2352 x 1568 pixels; retinal fundus photograph; 45° FOV — 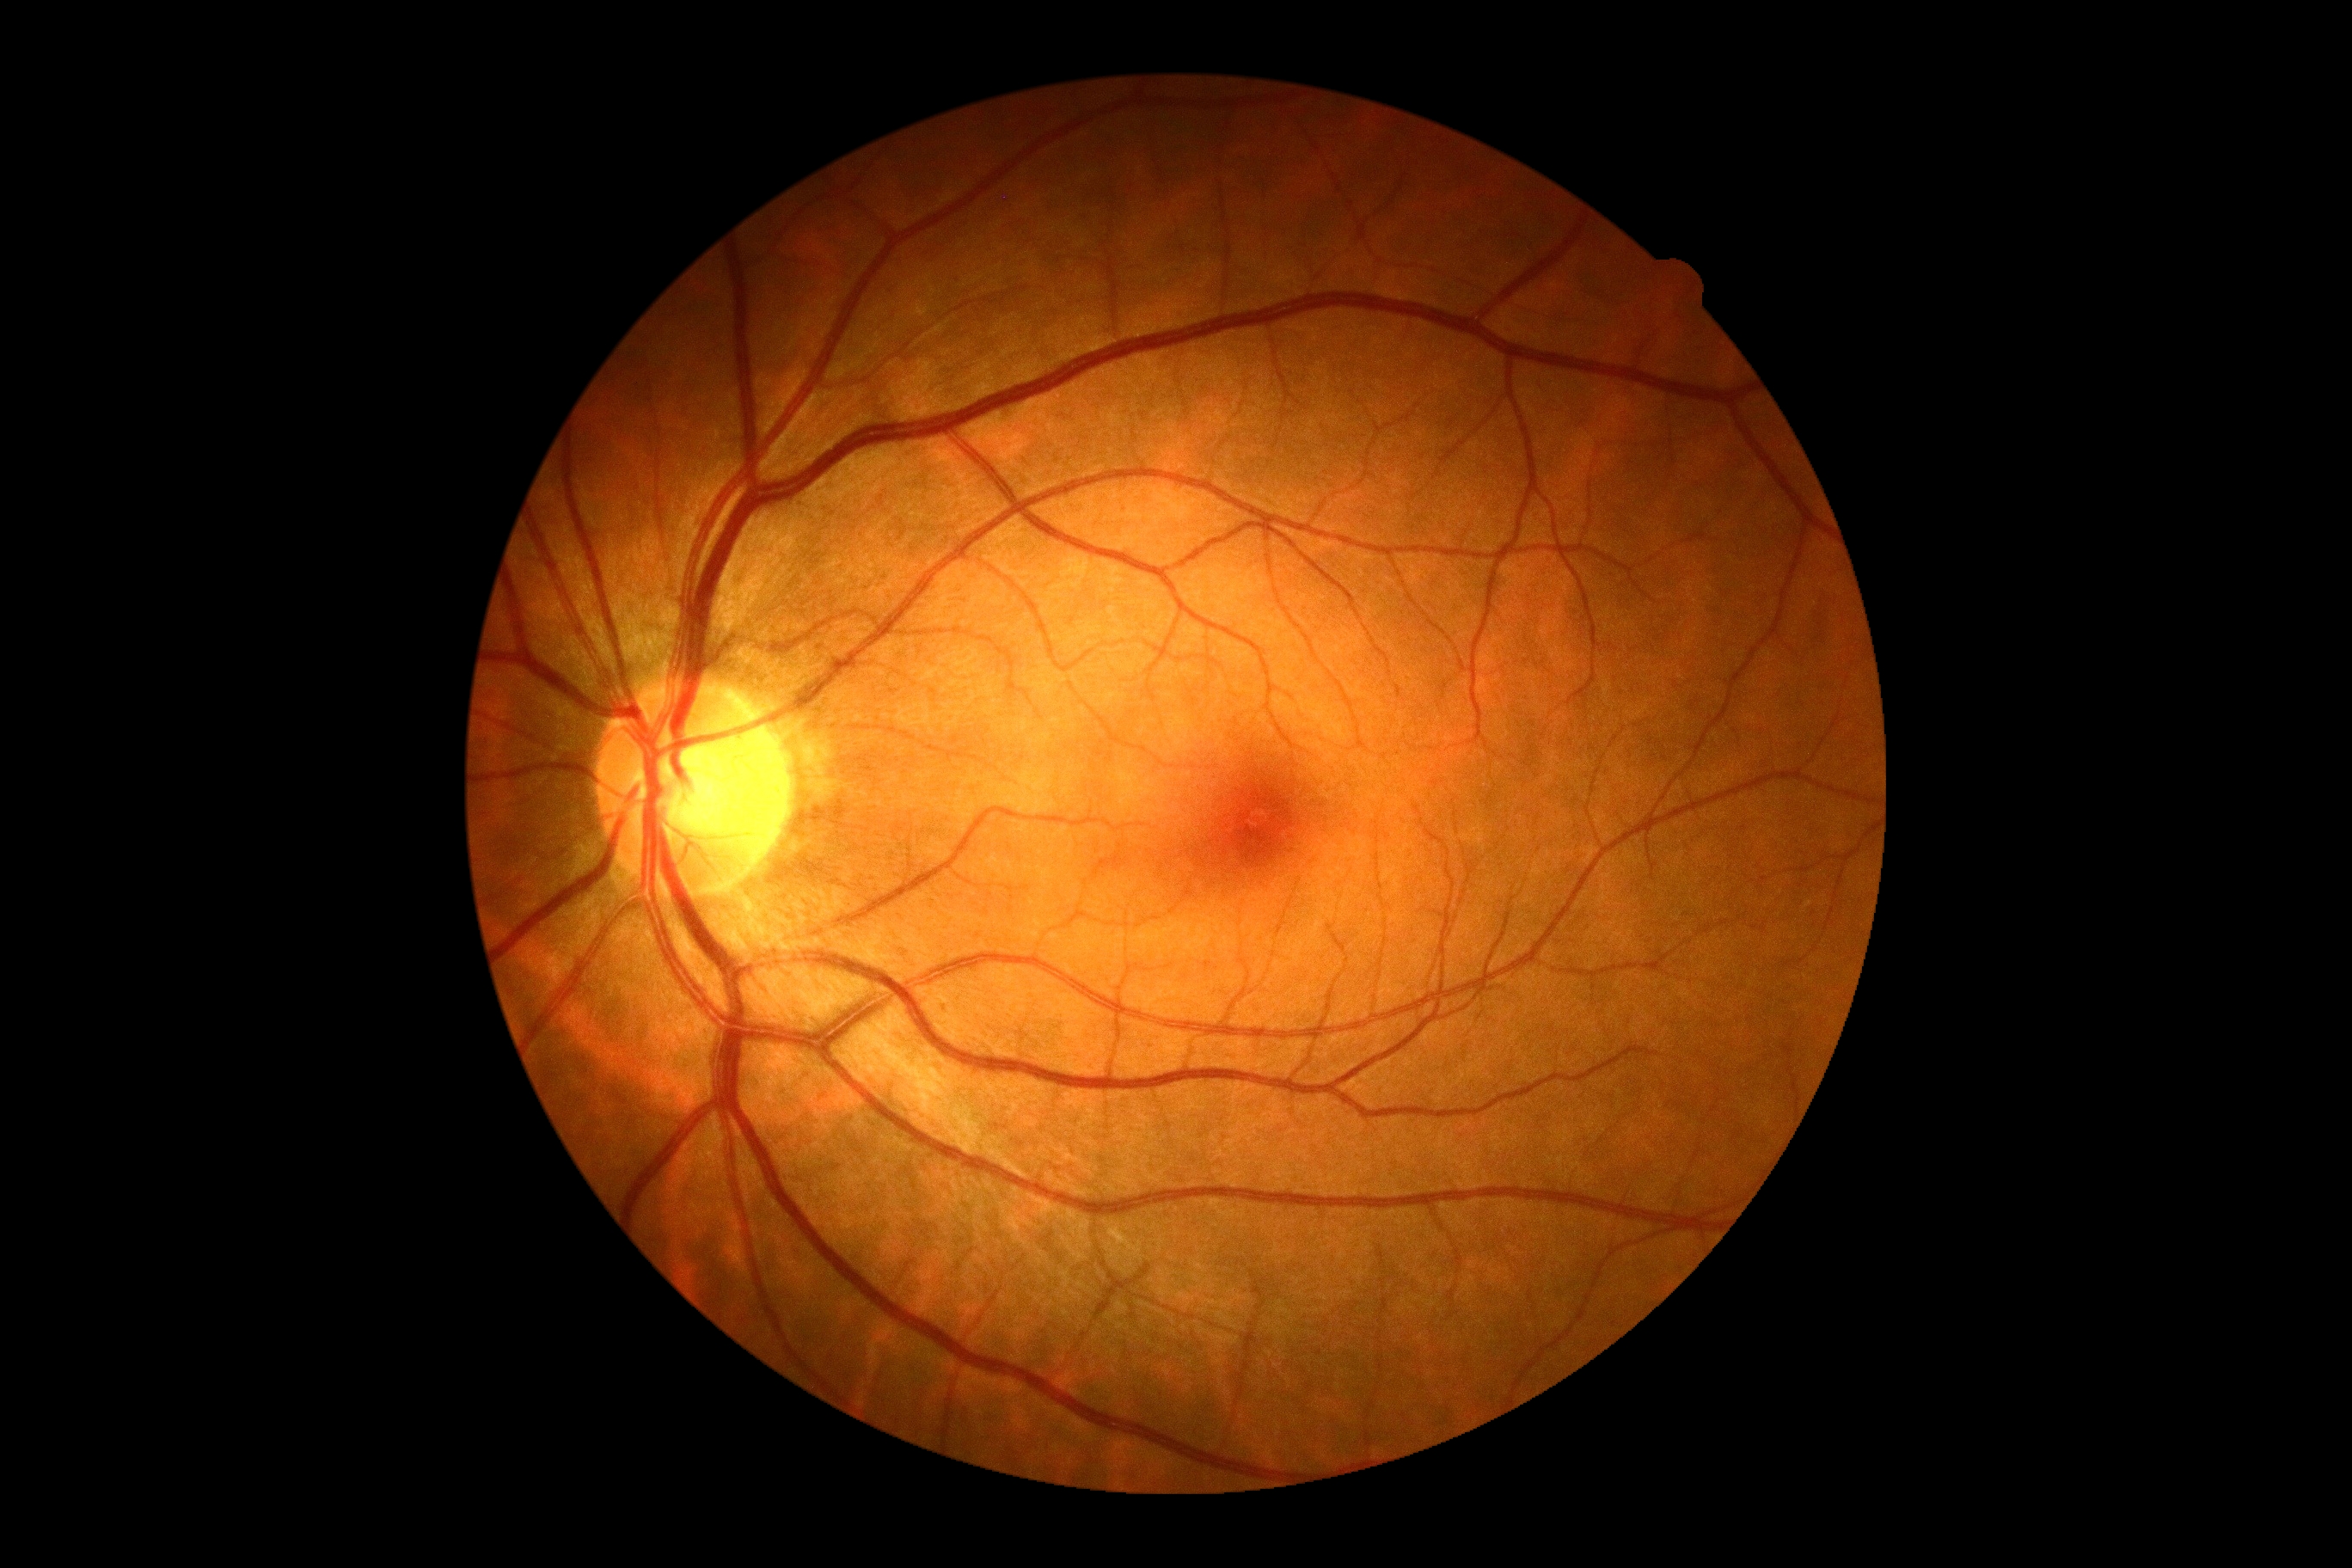 DR grade is 0.